848 by 848 pixels, 45° field of view, without pupil dilation, posterior pole photograph.
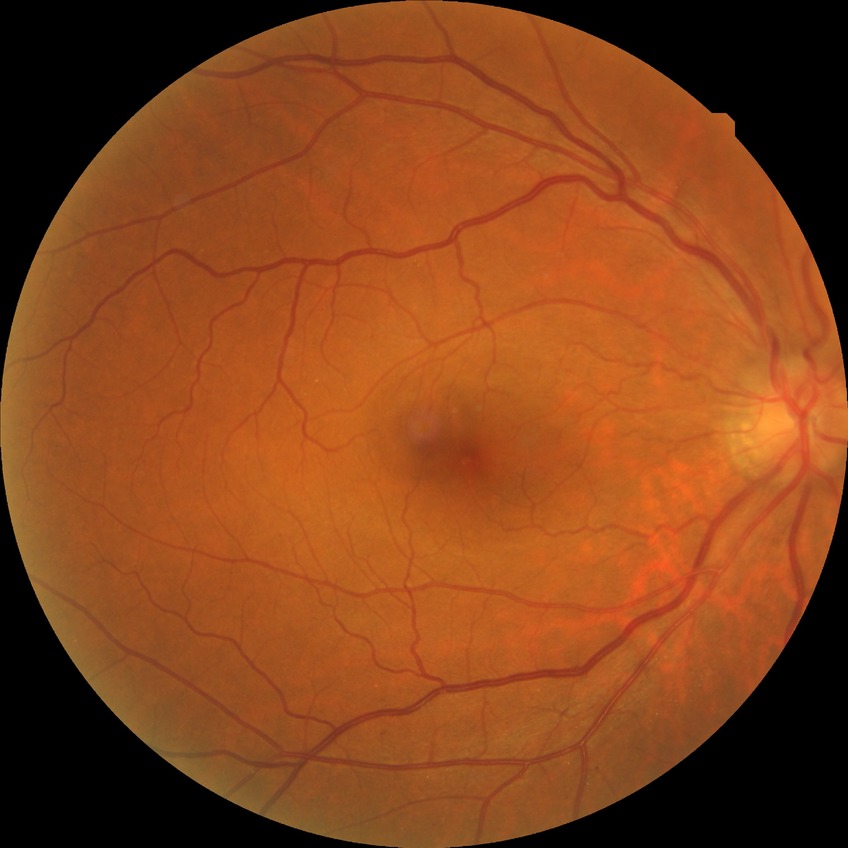
Annotations:
– diabetic retinopathy (DR): simple diabetic retinopathy (SDR)